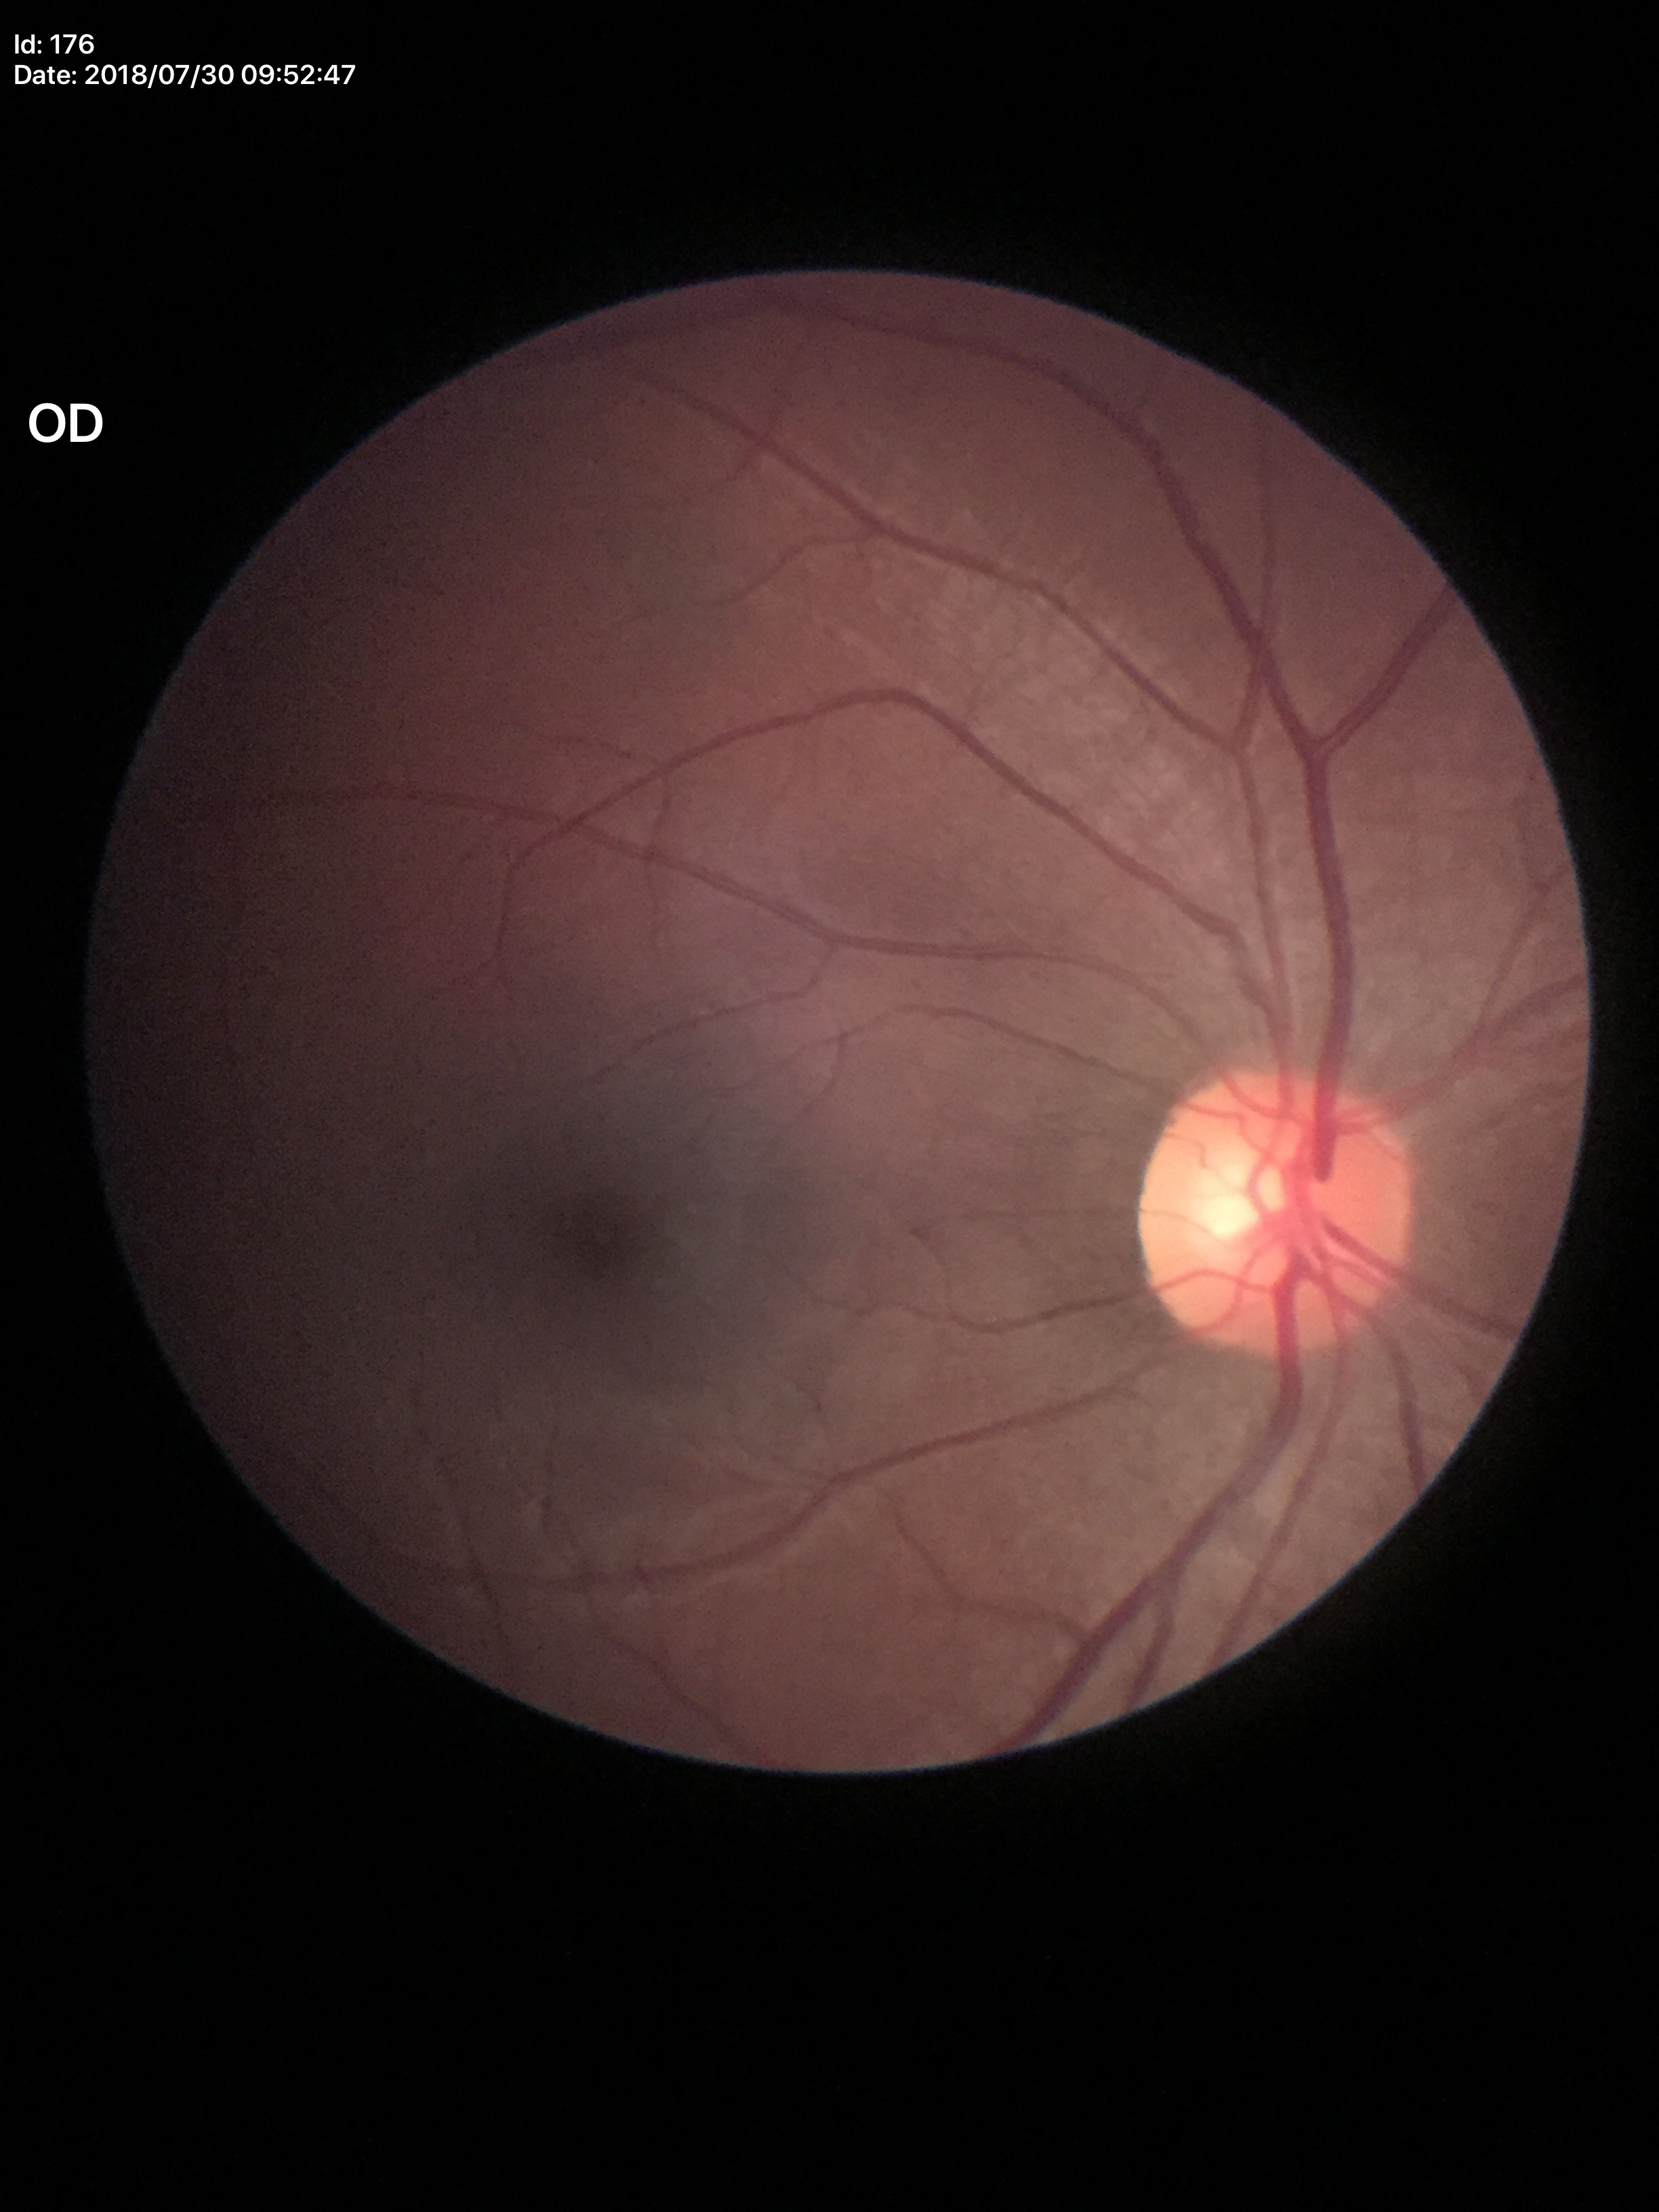
VCDR is 0.53.
Glaucoma assessment: negative (1 of 5 graders flagged glaucoma suspect).
ACDR of 0.28.